DR severity per modified Davis staging. Color fundus image.
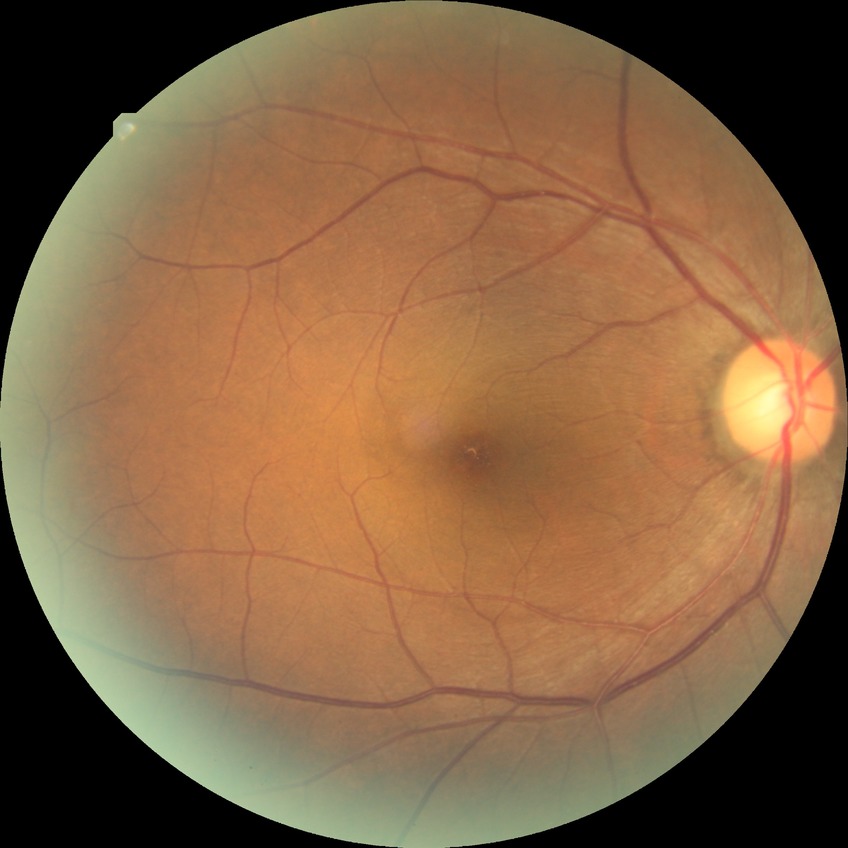 Diabetic retinopathy stage: no diabetic retinopathy.